45° field of view. Modified Davis grading — 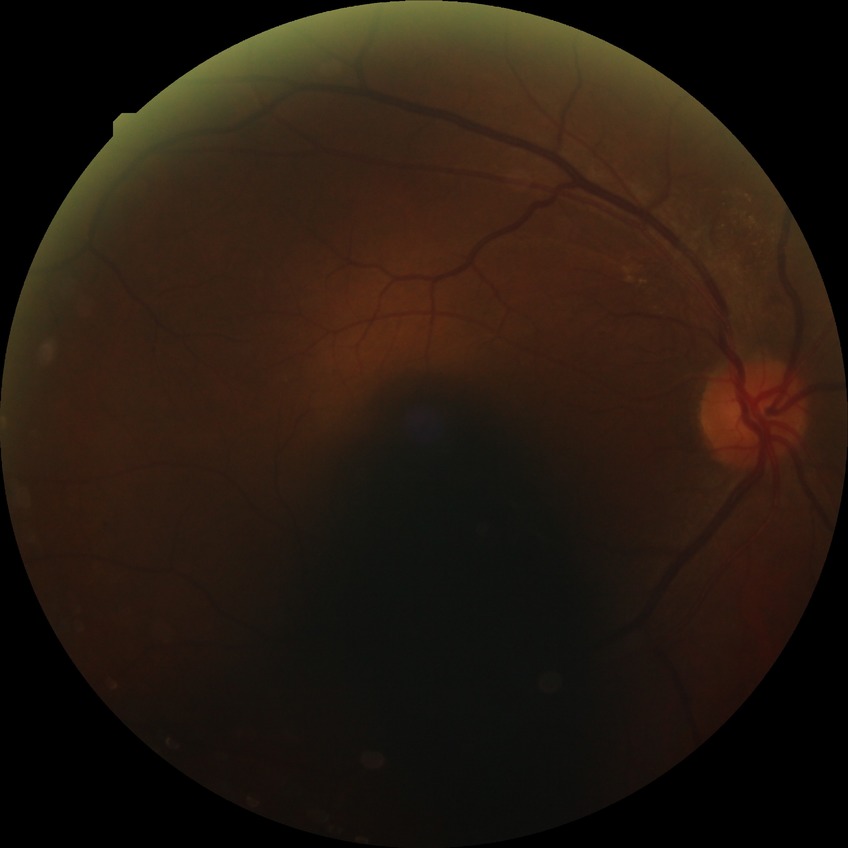

Diabetic retinopathy (DR) is SDR (simple diabetic retinopathy).